1659x2212: 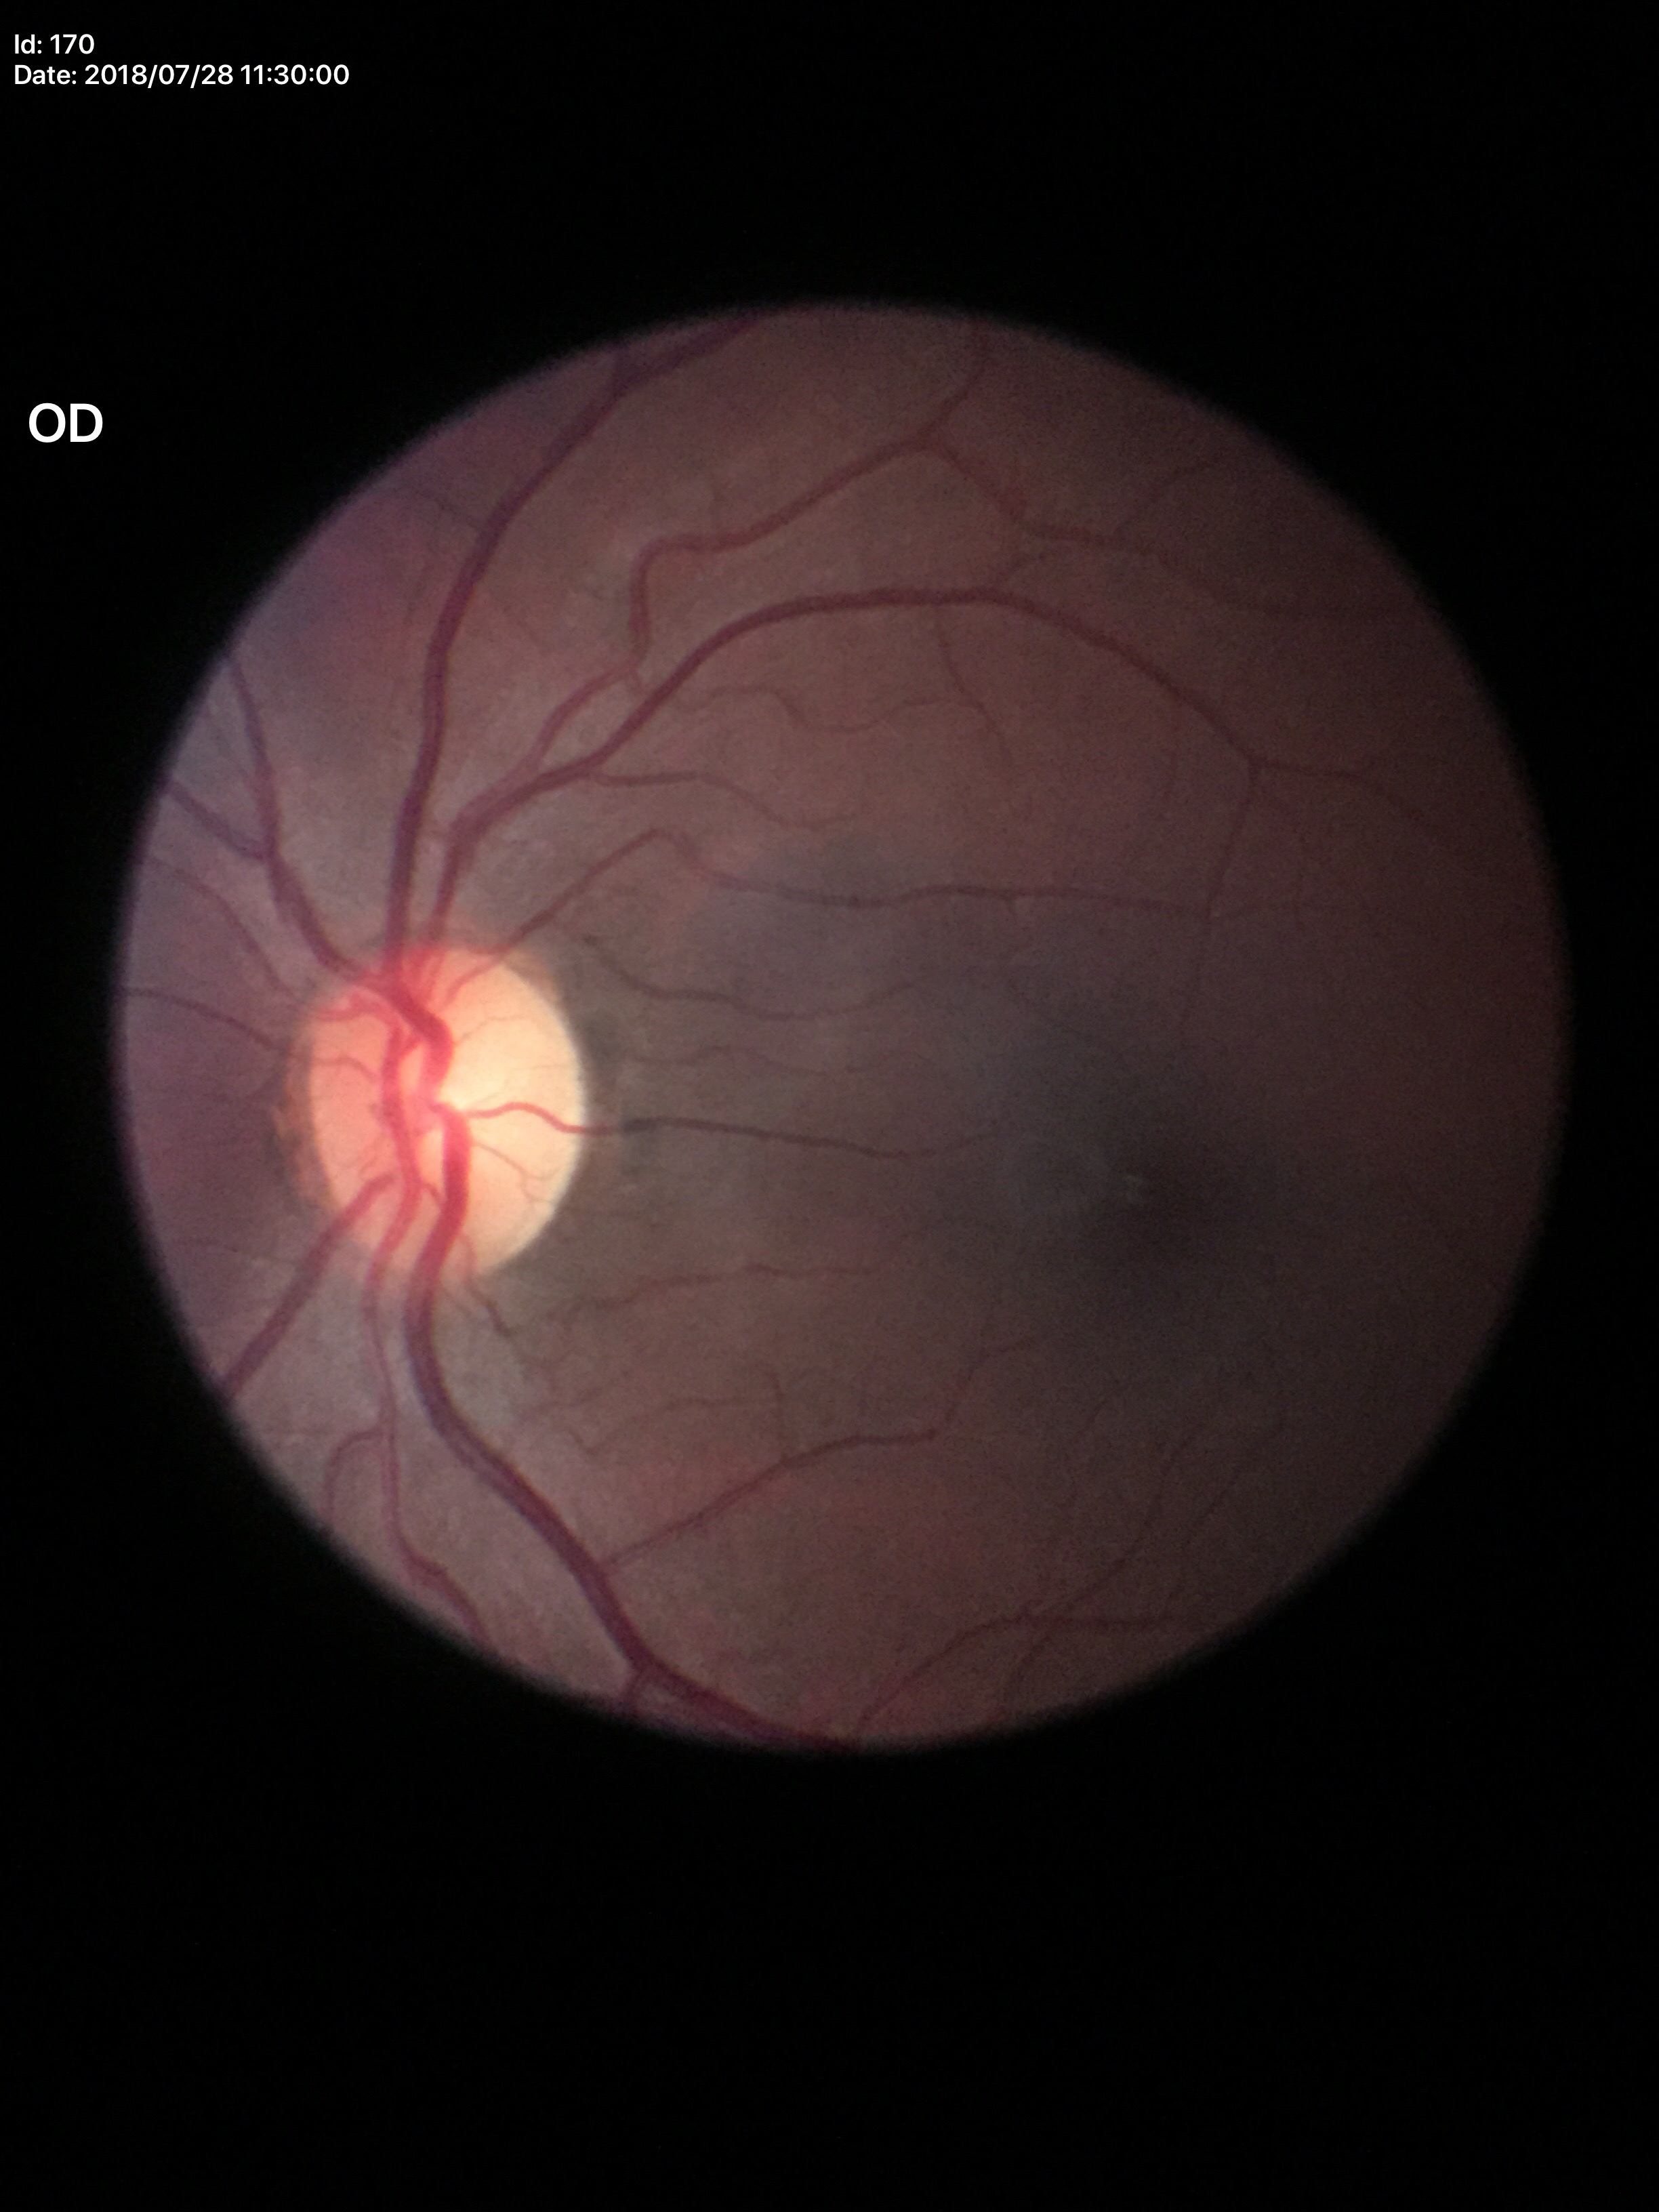

Glaucoma impression: no suspicious findings. Vertical cup-to-disc ratio (VCDR) of 0.51. Horizontal C/D ratio (HCDR) of 0.50.